CFP
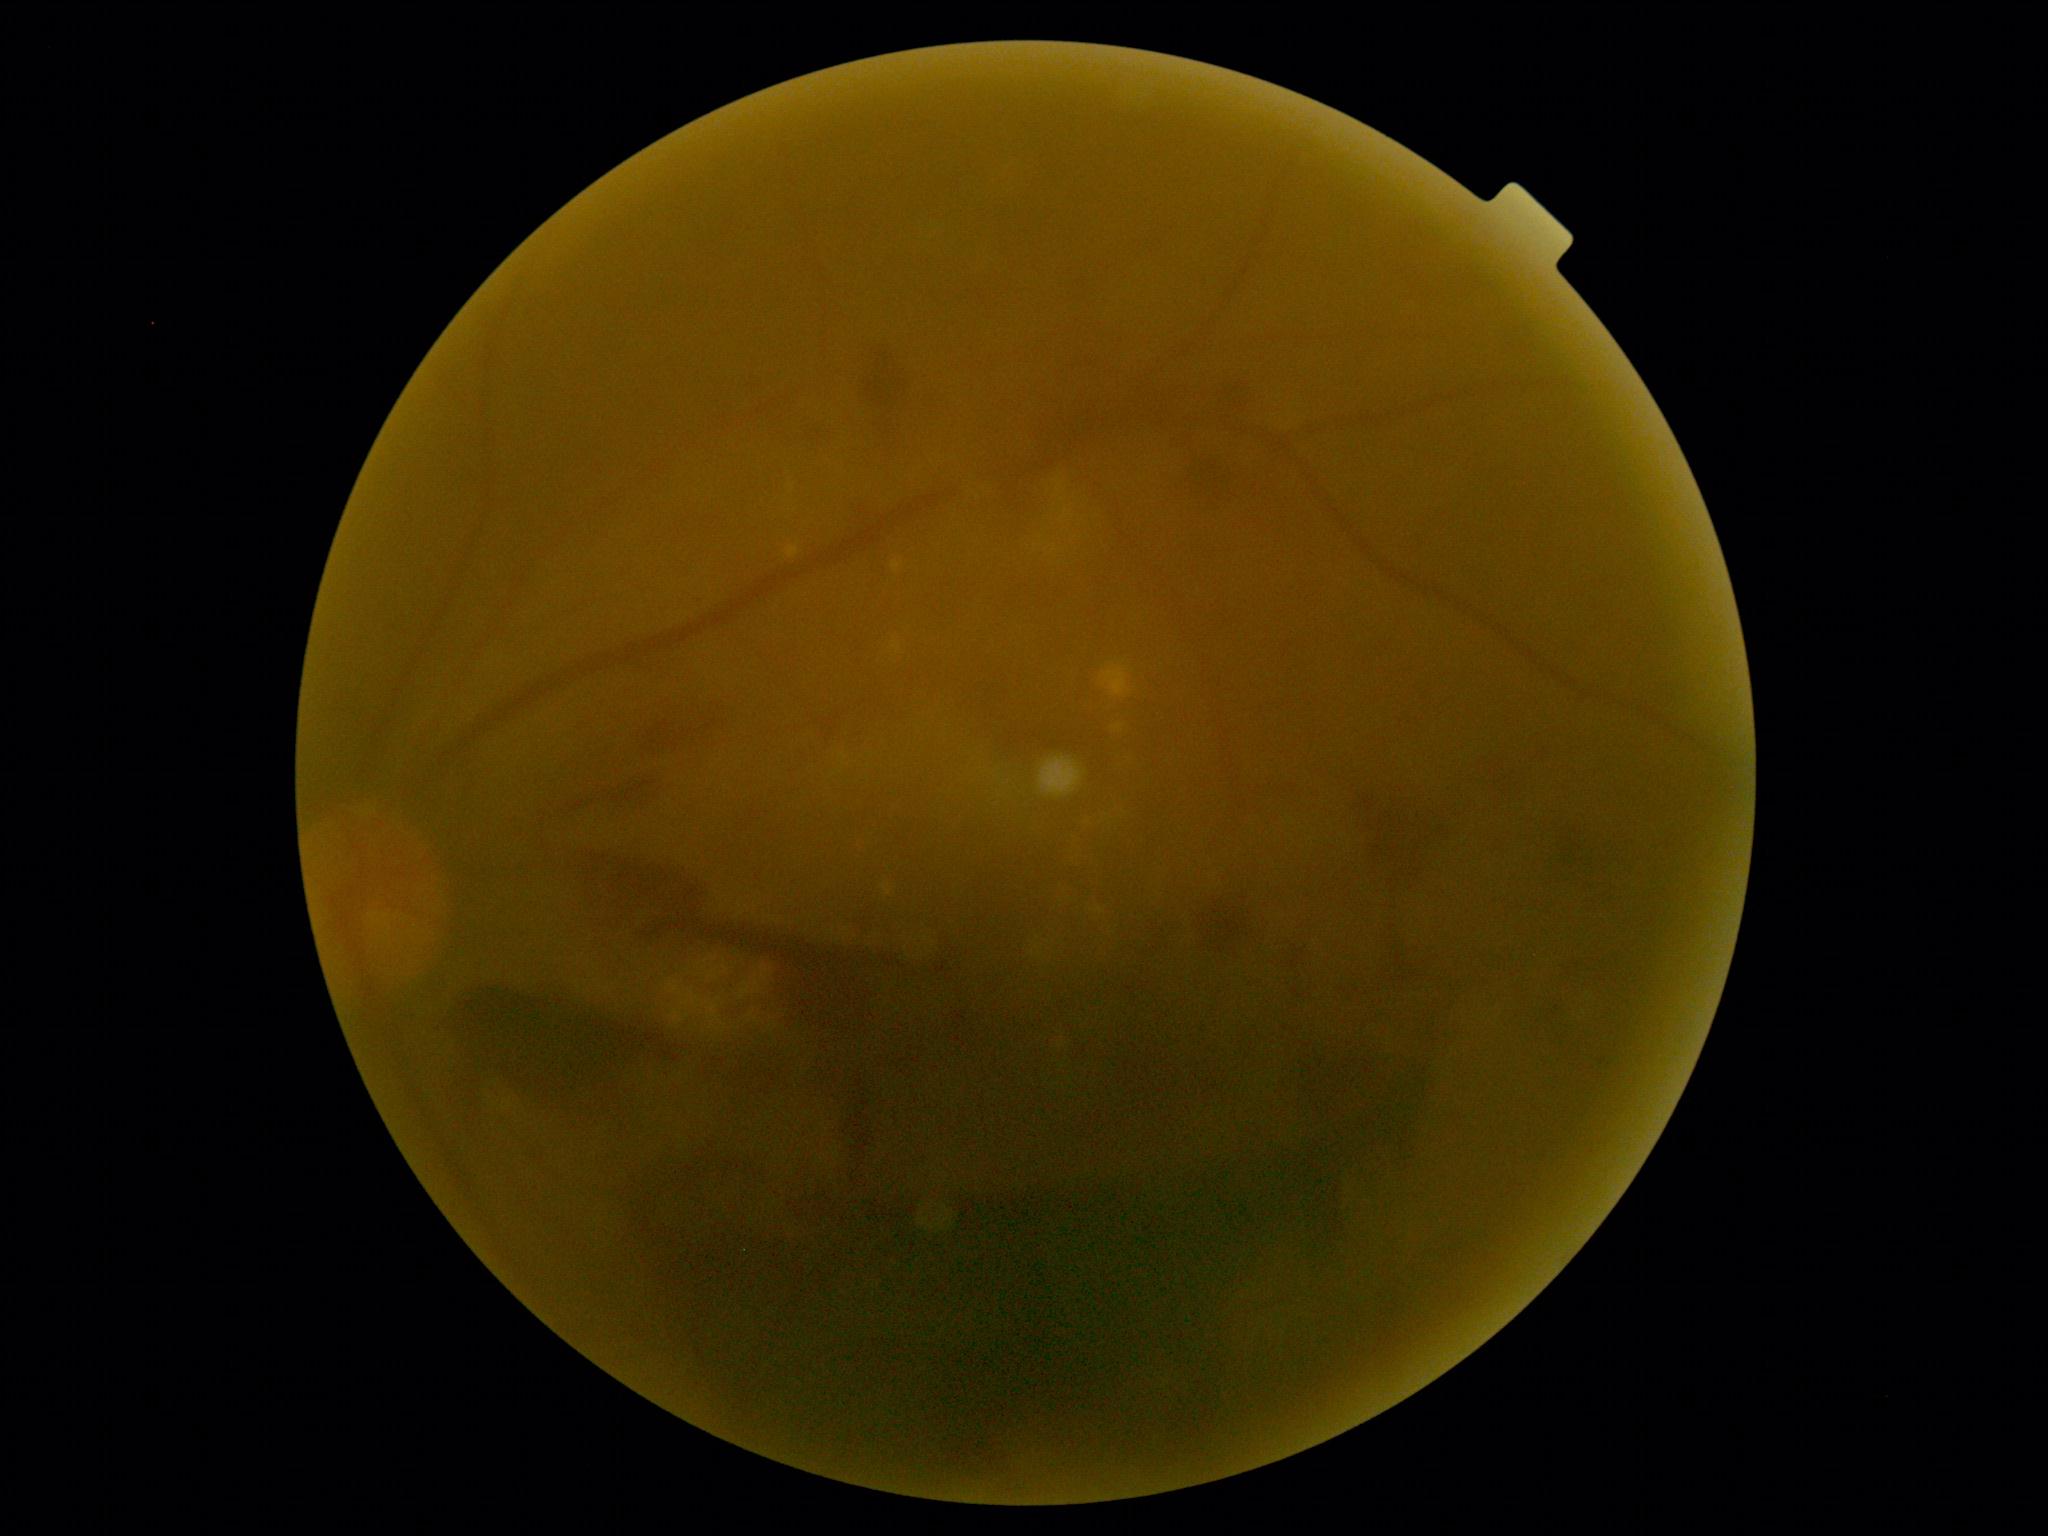 diabetic retinopathy grade = 4/4.